Wide-field fundus photograph from neonatal ROP screening; image size 1240x1240 — 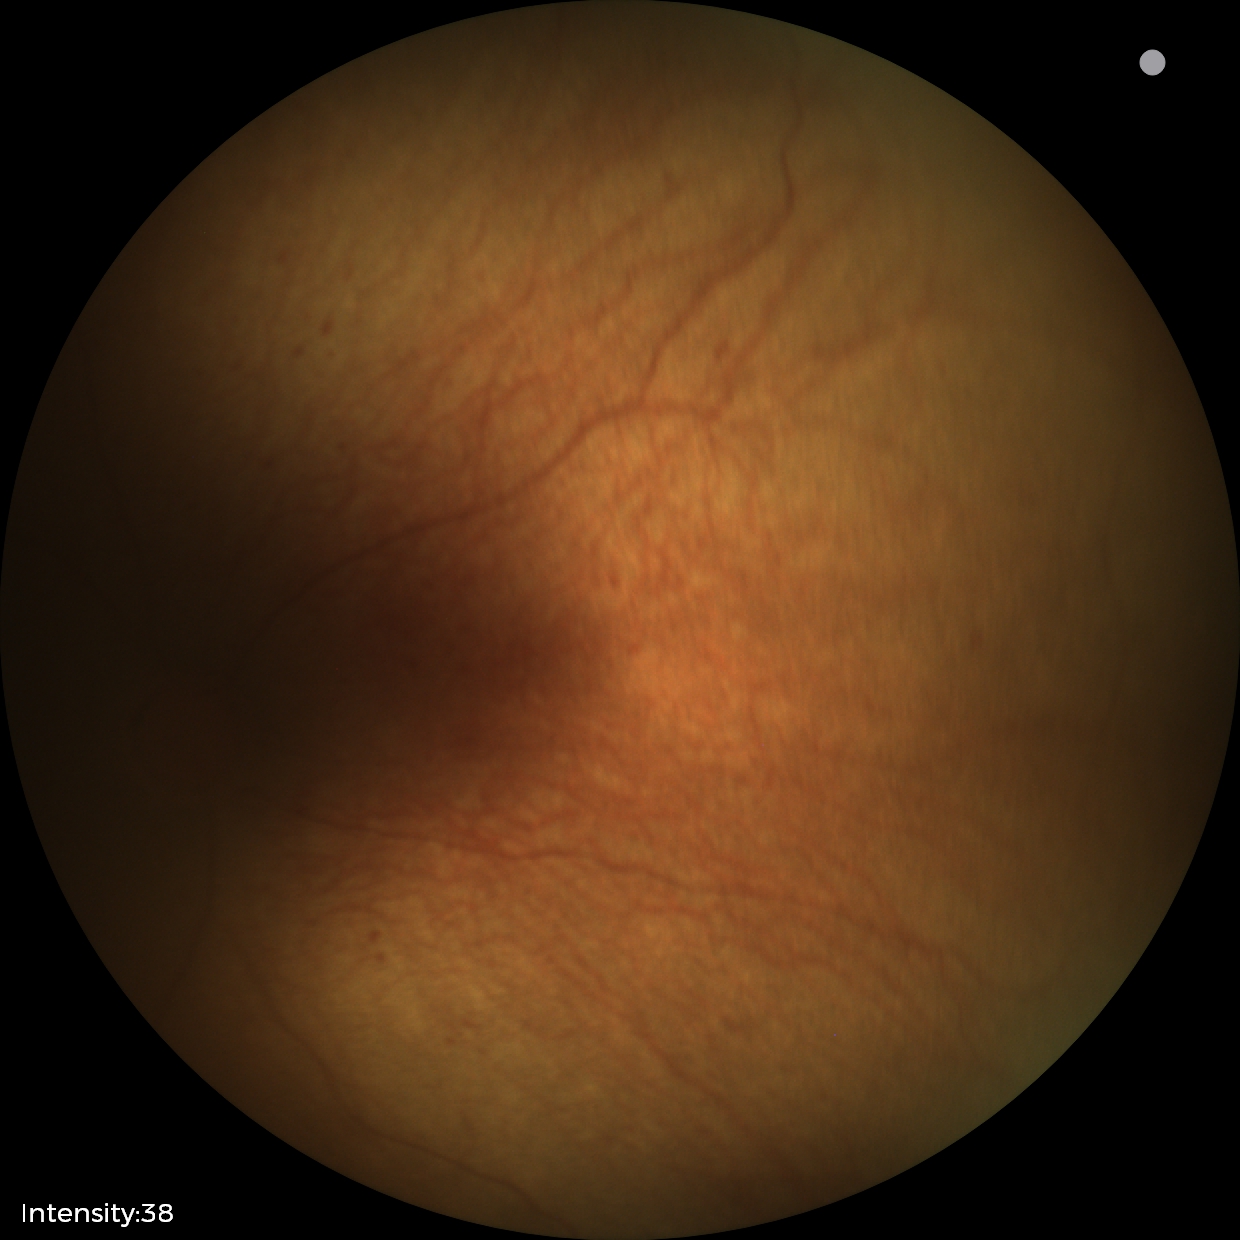

Screening diagnosis: status post ROP; no plus disease.